45-degree field of view · 848 x 848 pixels · posterior pole color fundus photograph · graded on the modified Davis scale:
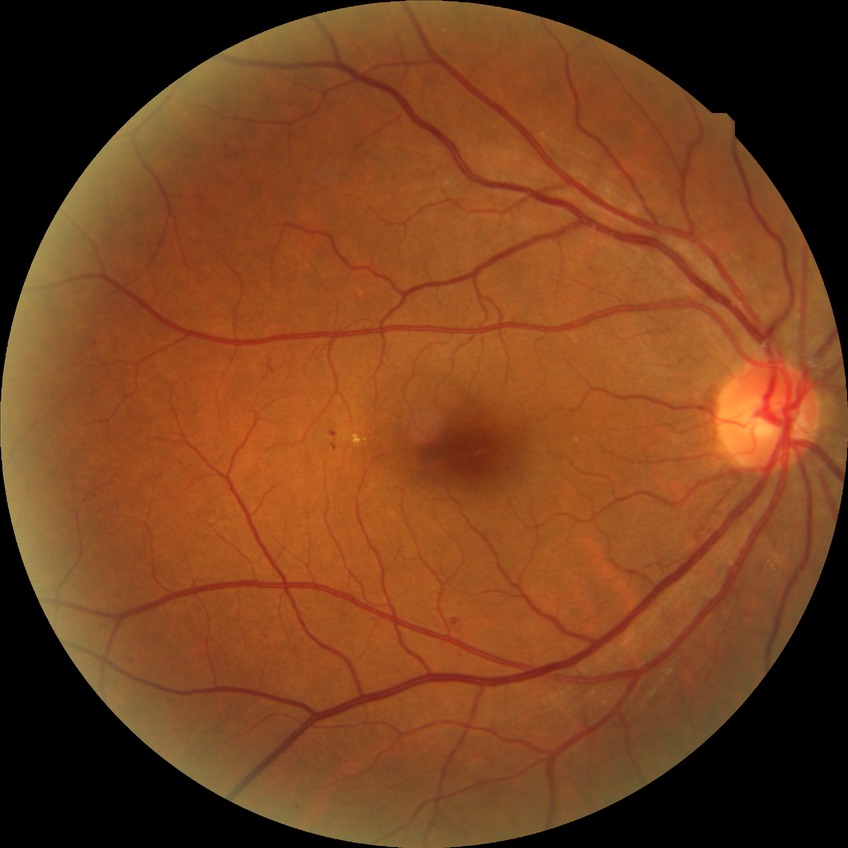   davis_grade: SDR (simple diabetic retinopathy)